45-degree field of view · fundus photo — 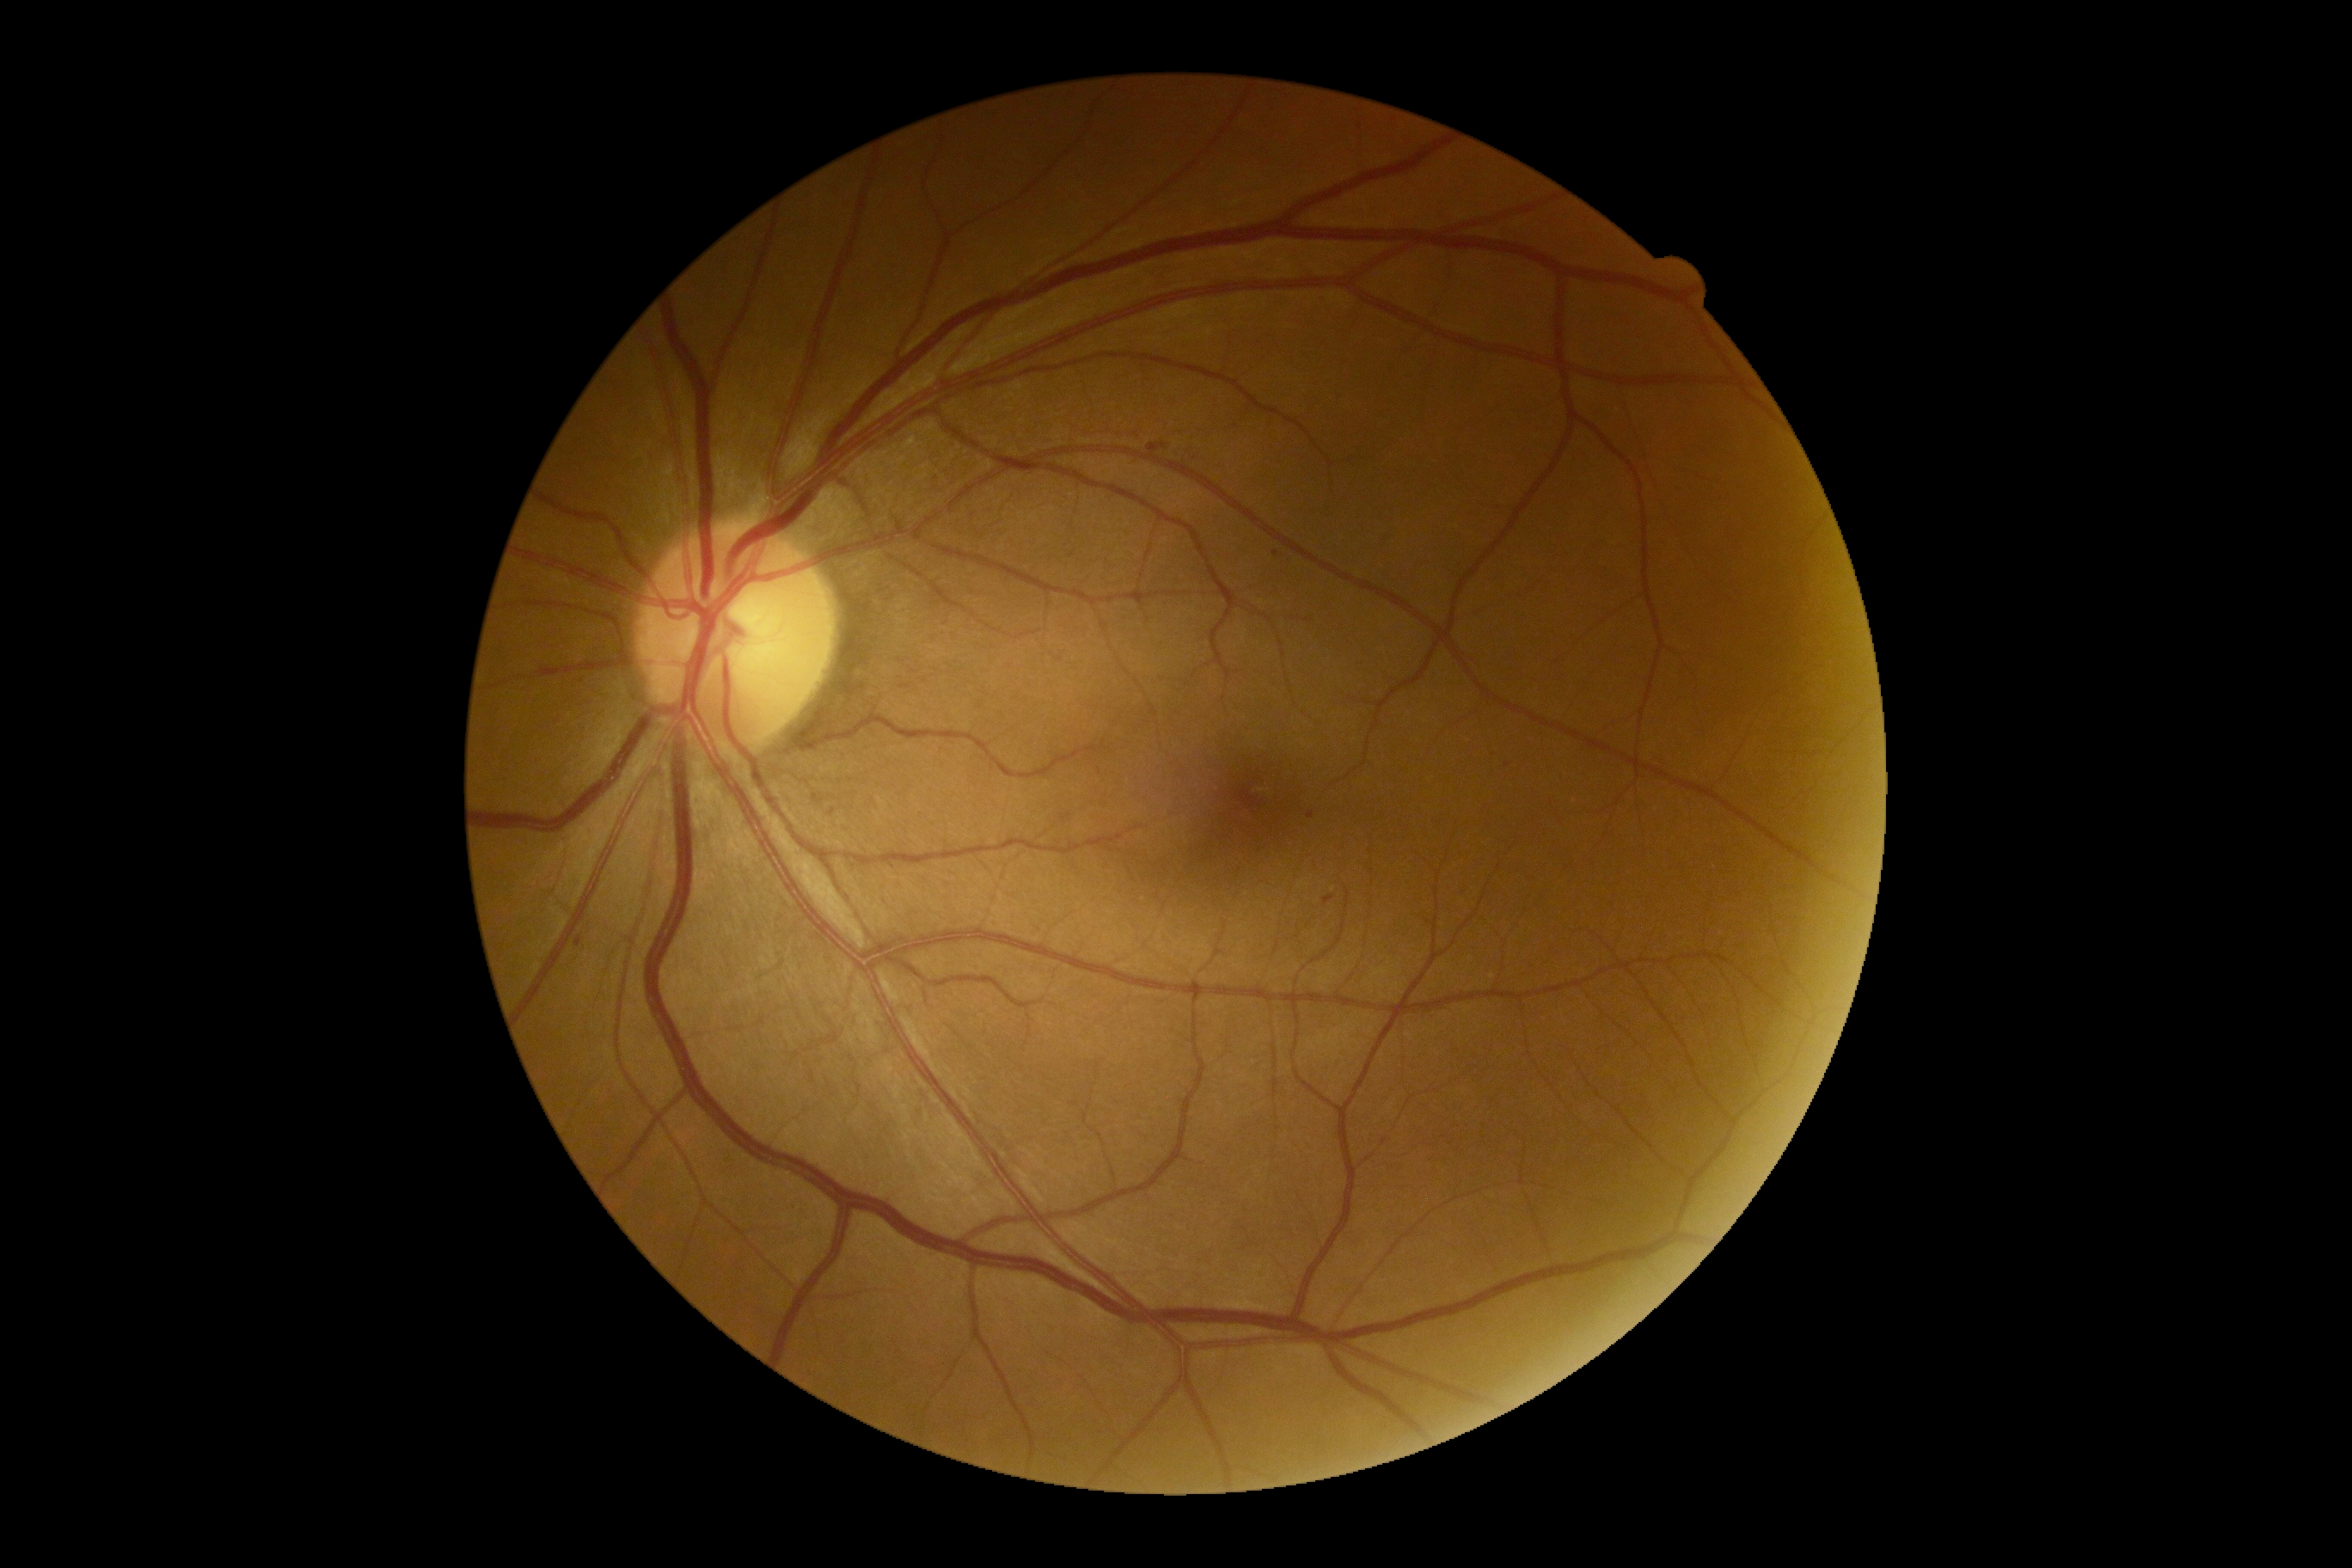 {"dr_category": "non-proliferative diabetic retinopathy", "dr_grade": "2/4"}